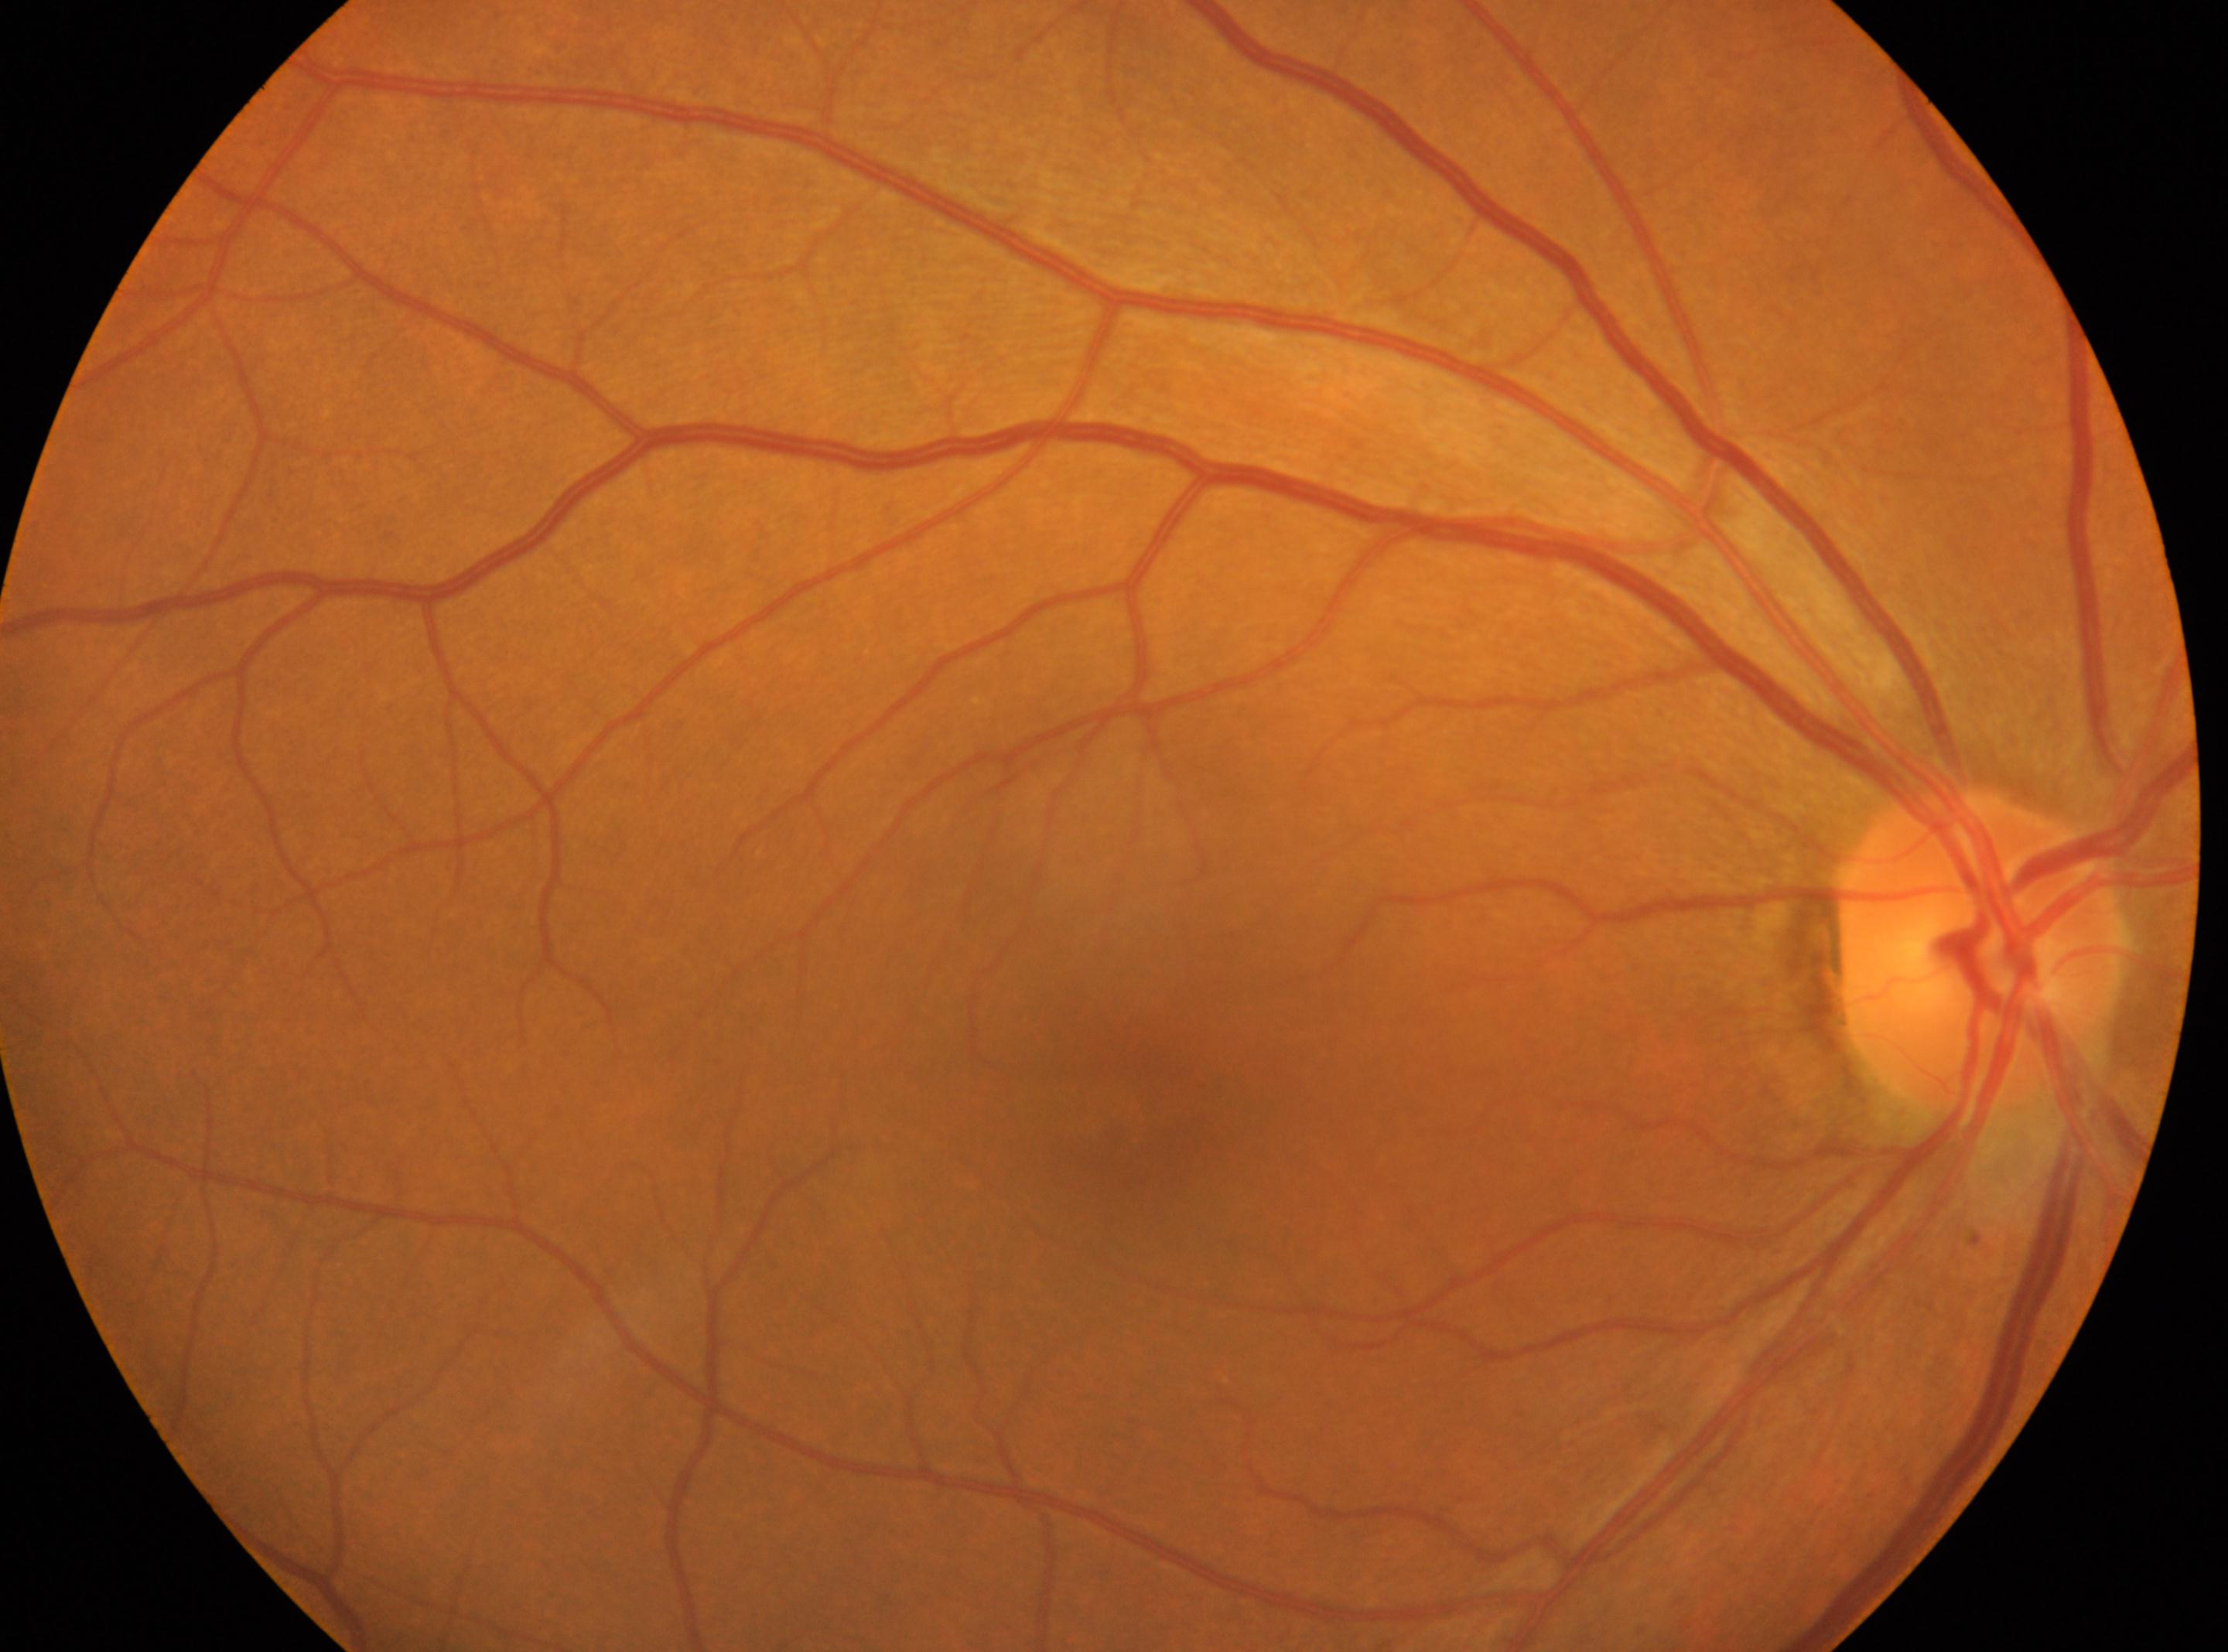 Findings:
– macula center — (1120, 1121)
– DR impression — No apparent diabetic retinopathy
– laterality — right eye
– DR — grade 0 (no apparent retinopathy) — no visible signs of diabetic retinopathy
– optic nerve head — (1984, 948)